No pharmacologic dilation:
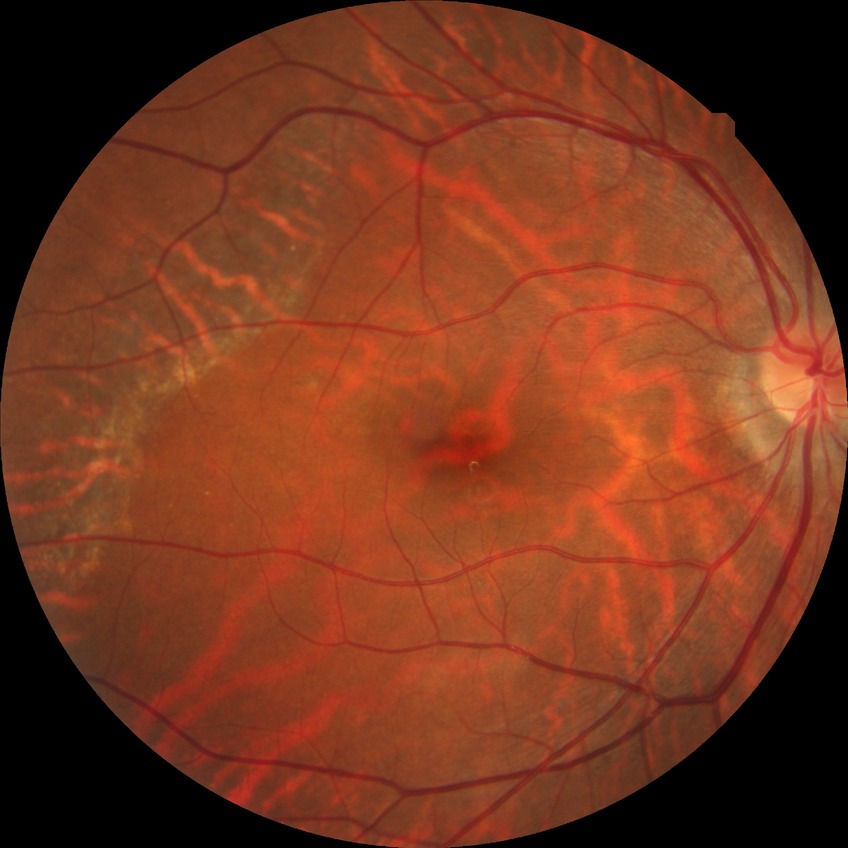
Diabetic retinopathy (DR) is no diabetic retinopathy (NDR).